Color fundus image — 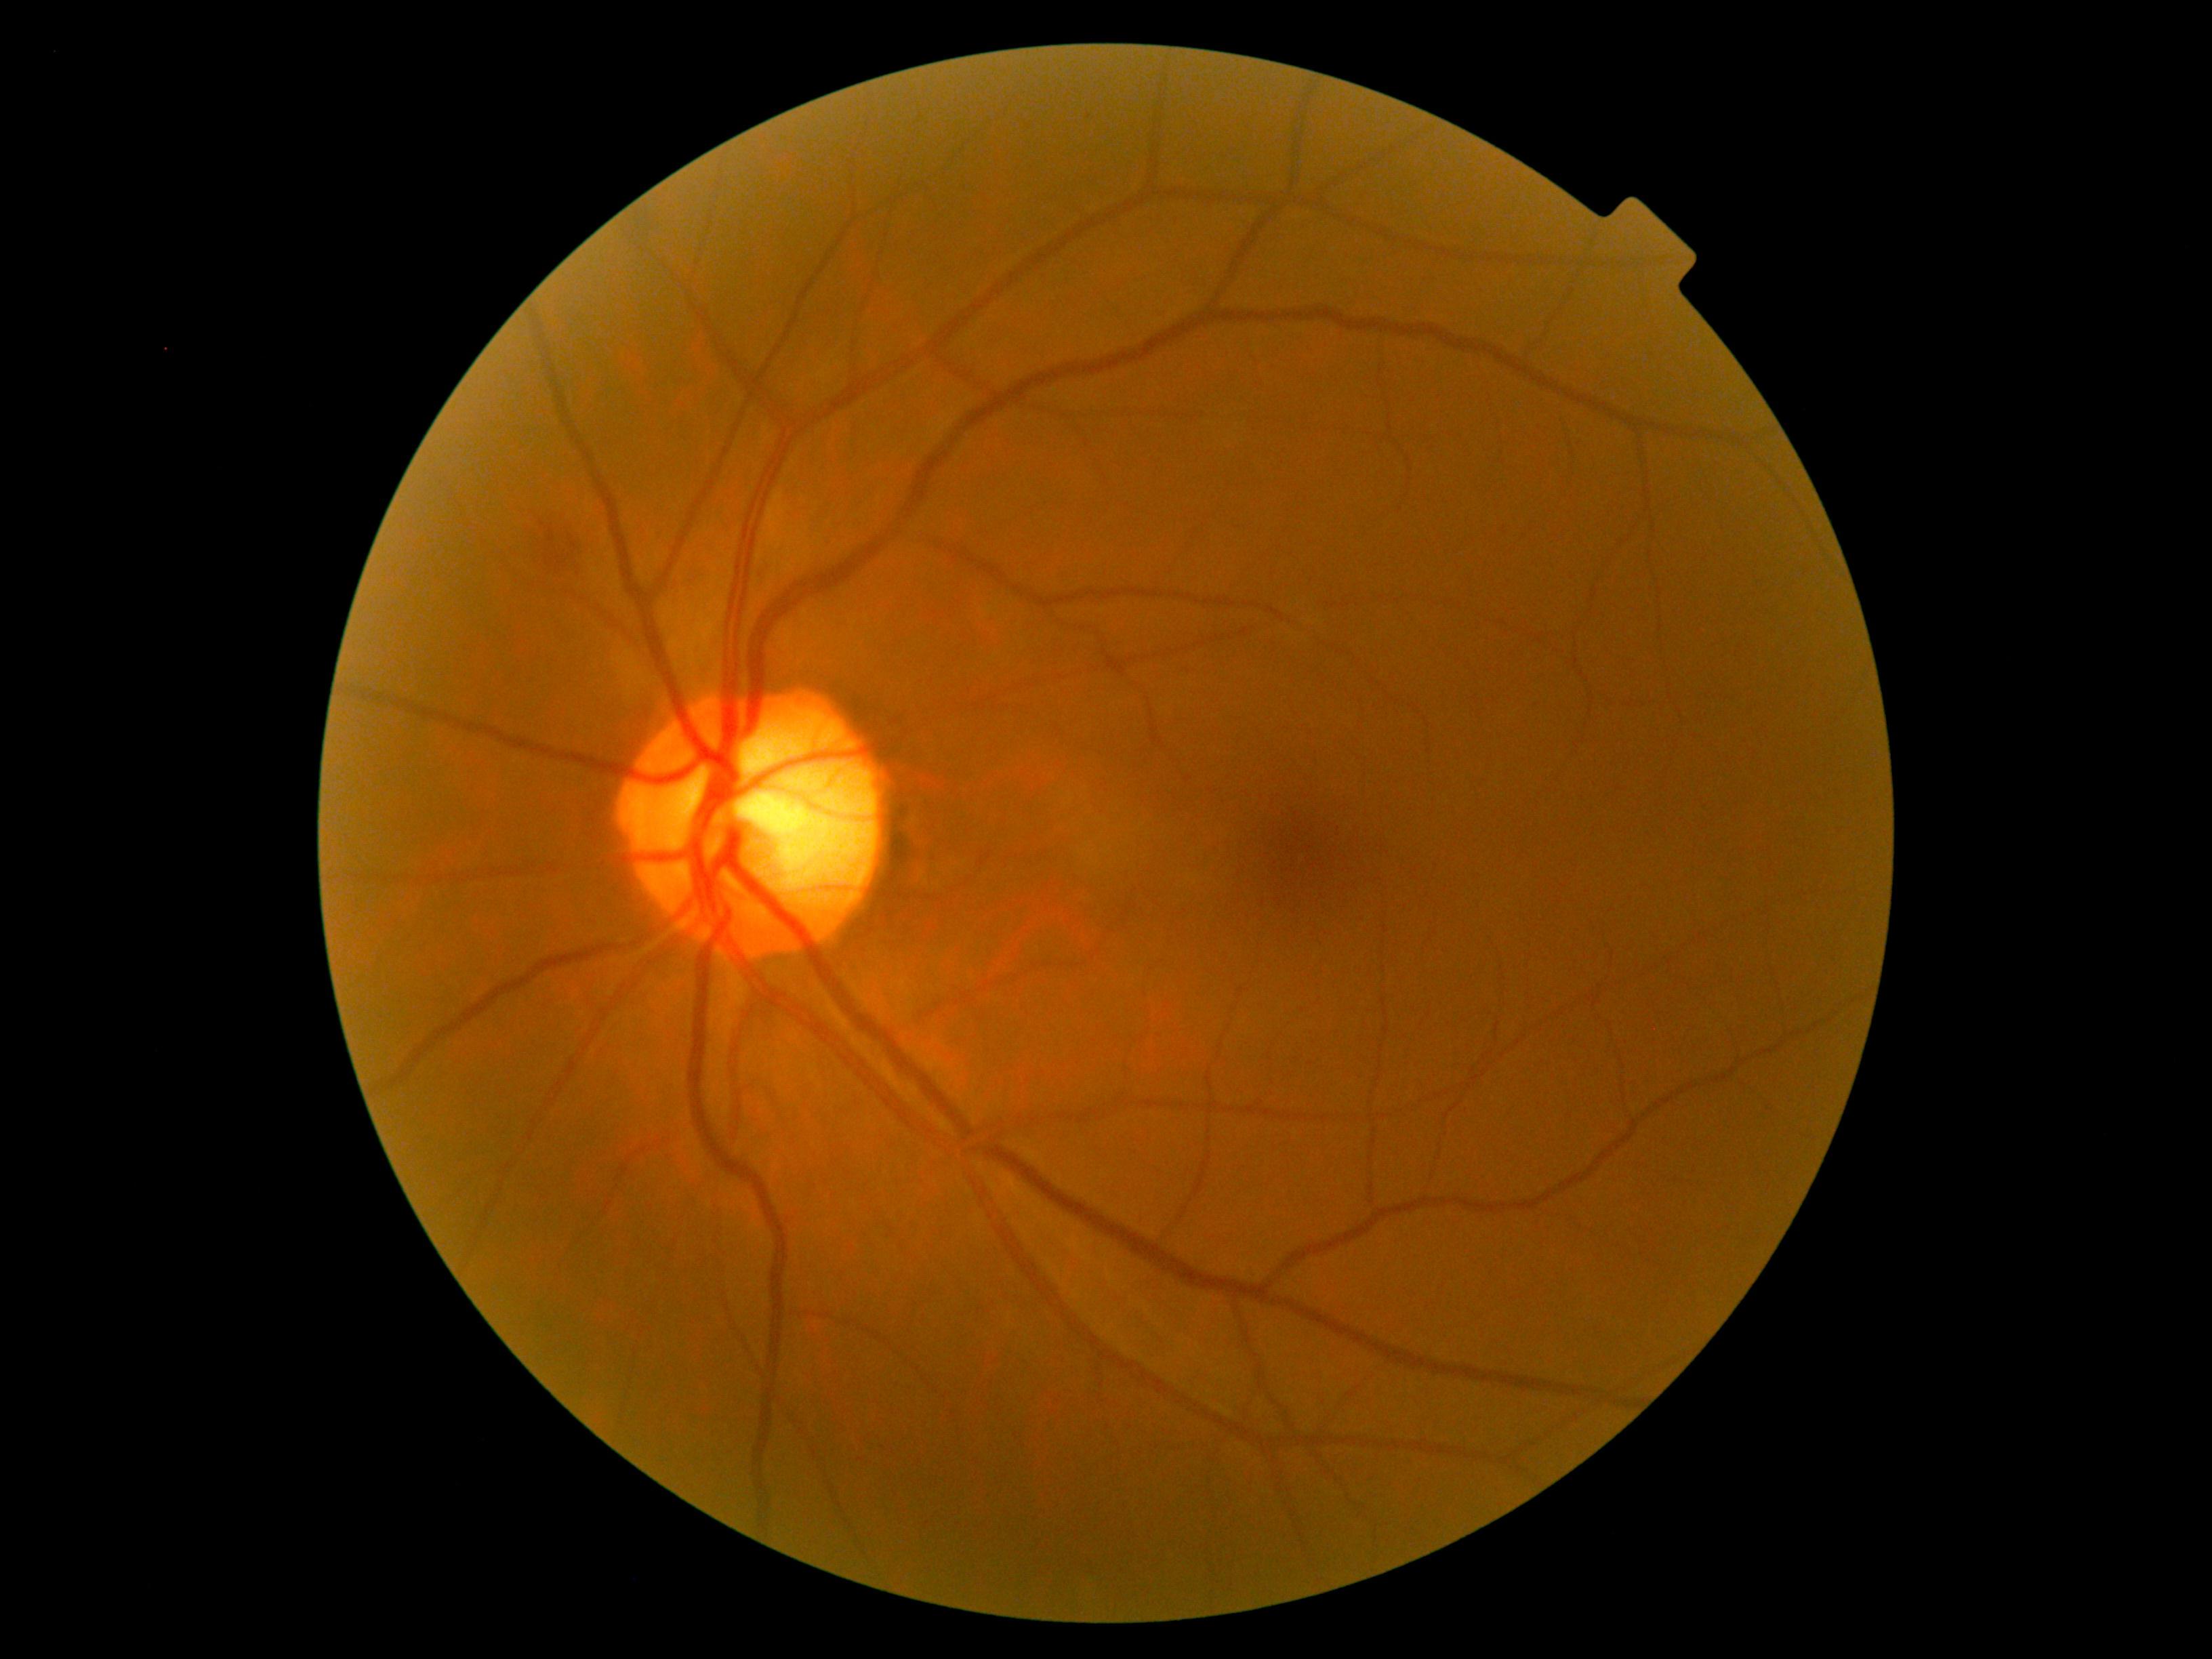
DR is 2.